Pediatric wide-field fundus photograph:
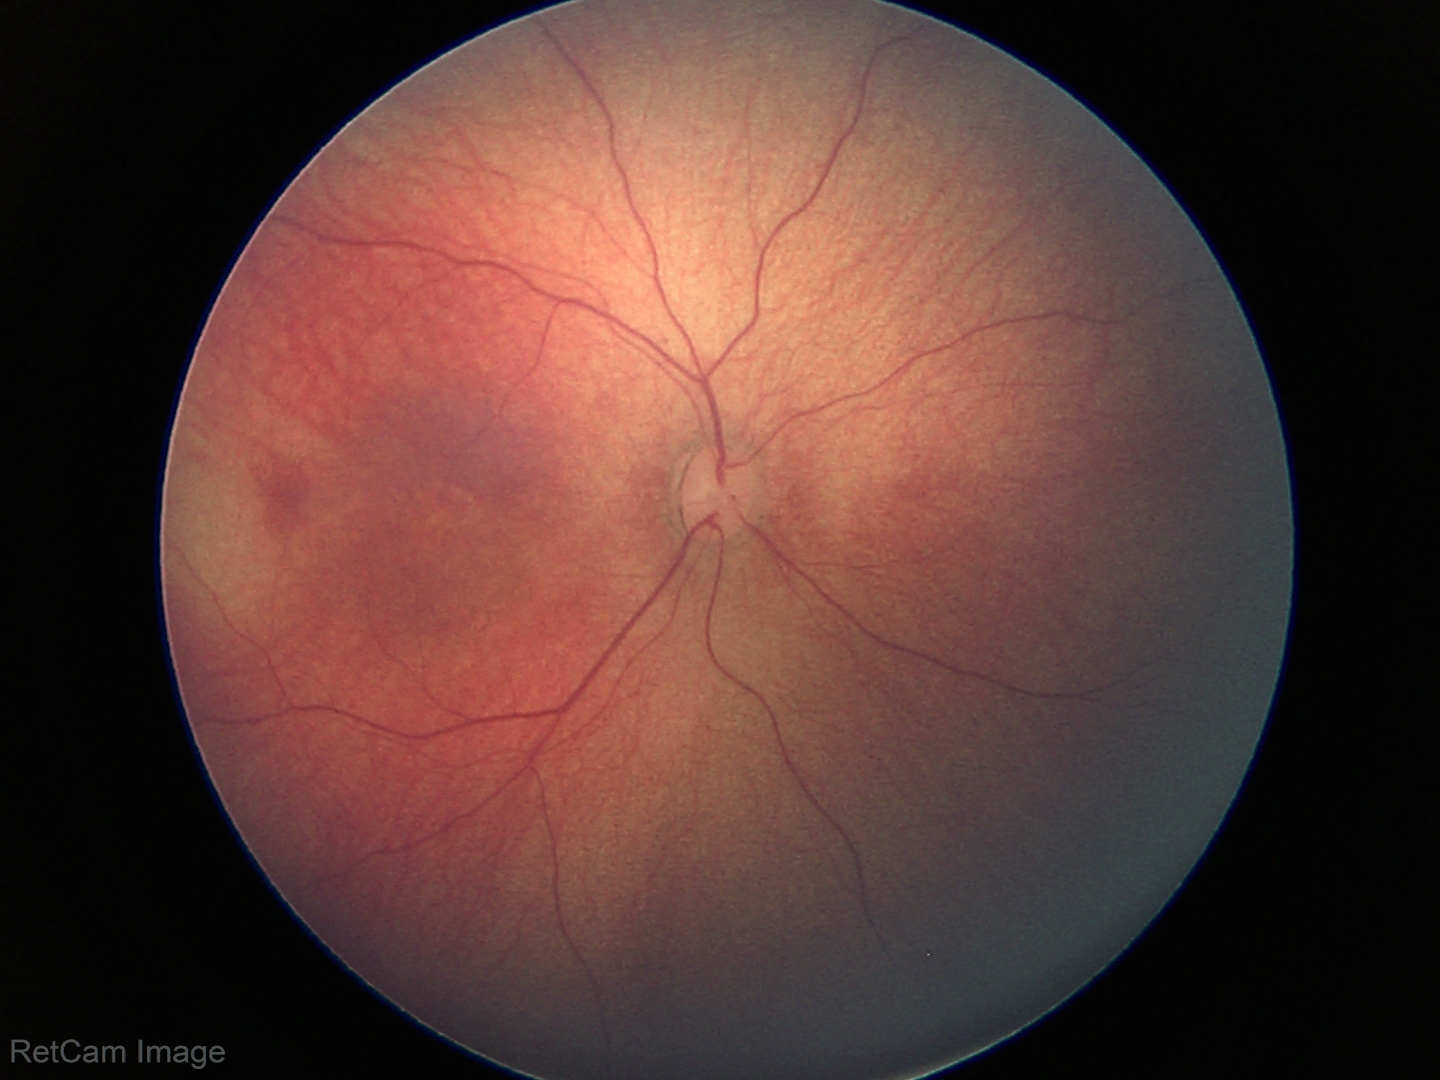
Normal screening examination.